Image size 1380x1382 · 45° FOV · color fundus photograph
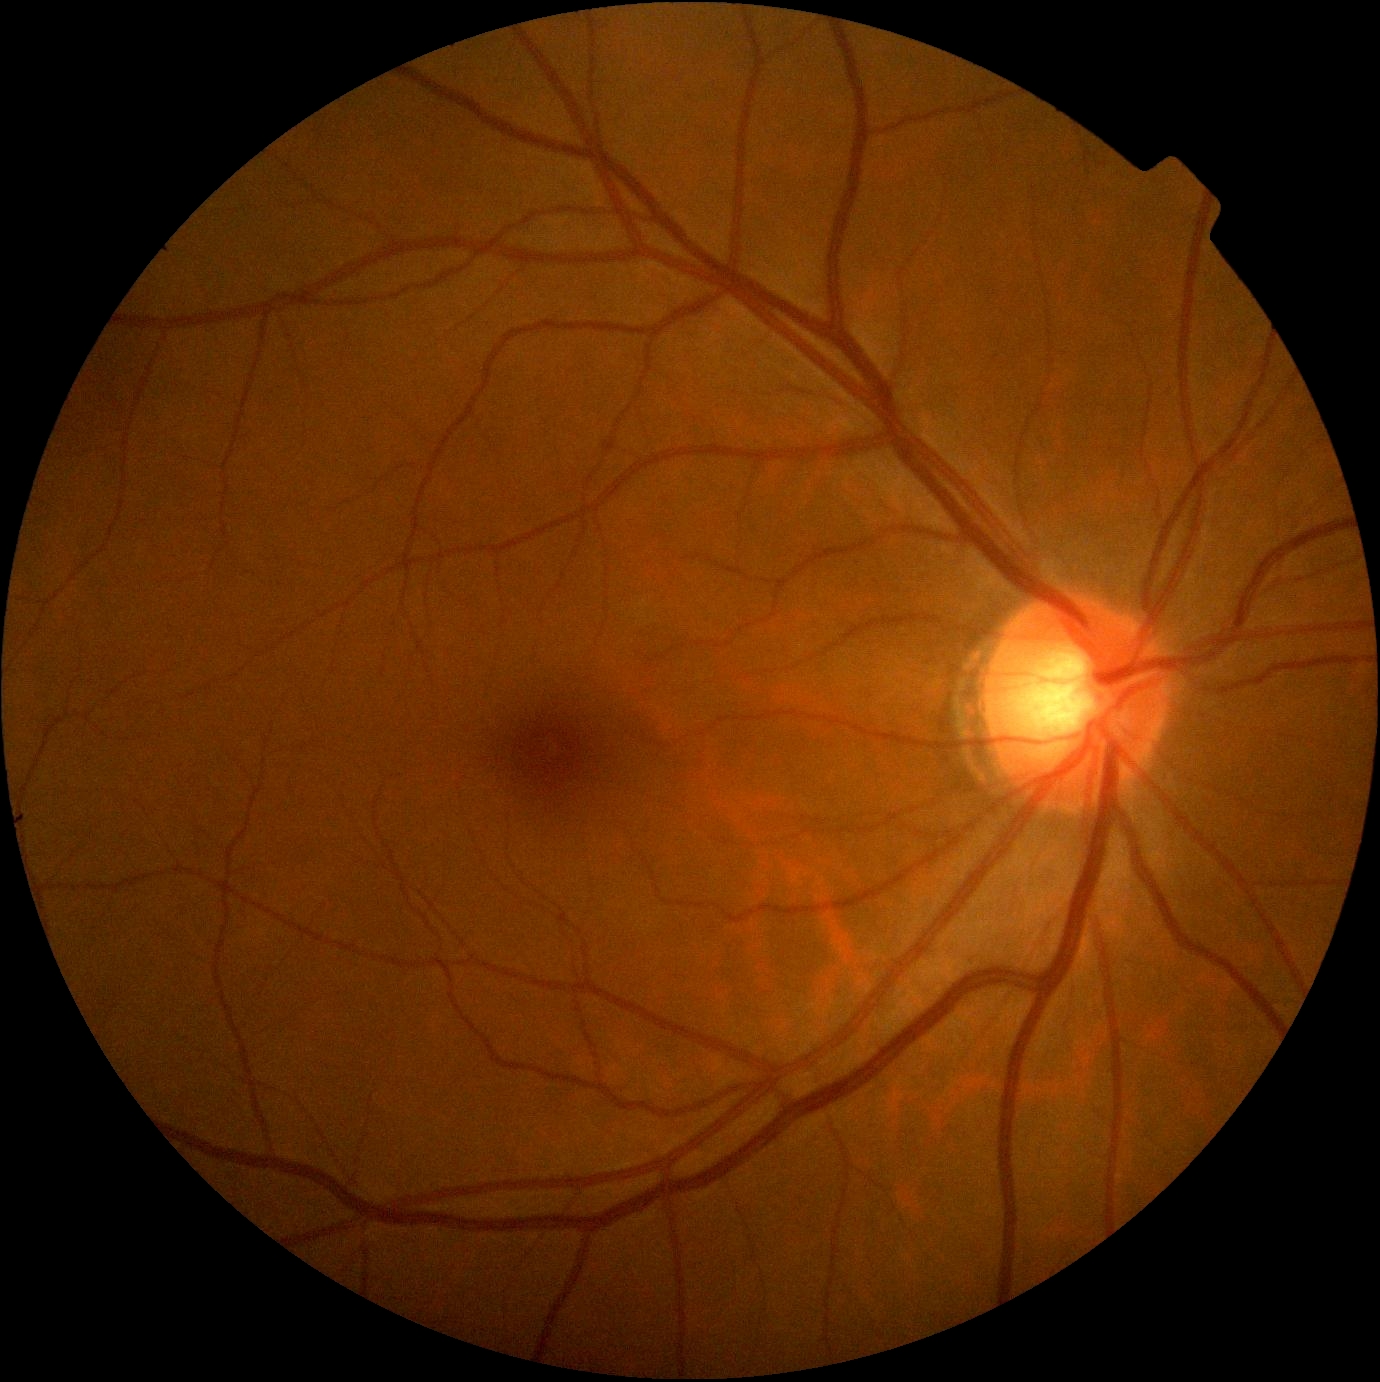
dr_grade: grade 0 (no apparent retinopathy)